Image size 848x848; camera: NIDEK AFC-230; FOV: 45 degrees; posterior pole color fundus photograph; nonmydriatic fundus photograph: 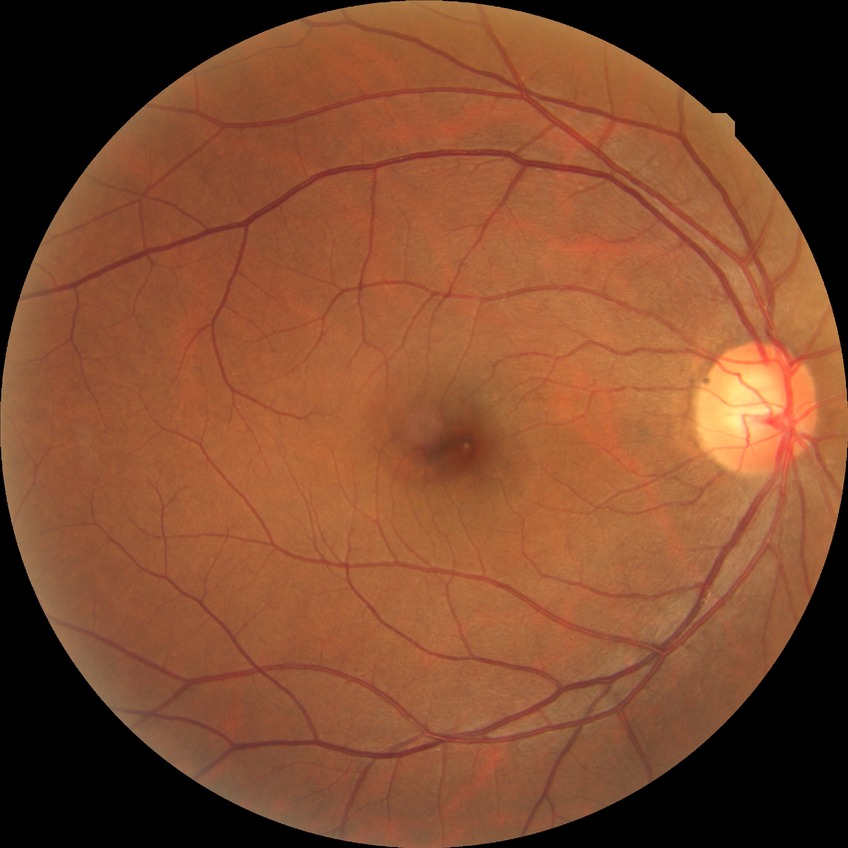
{"davis_grade": "no diabetic retinopathy"}